Without pupil dilation; acquired with a NIDEK AFC-230:
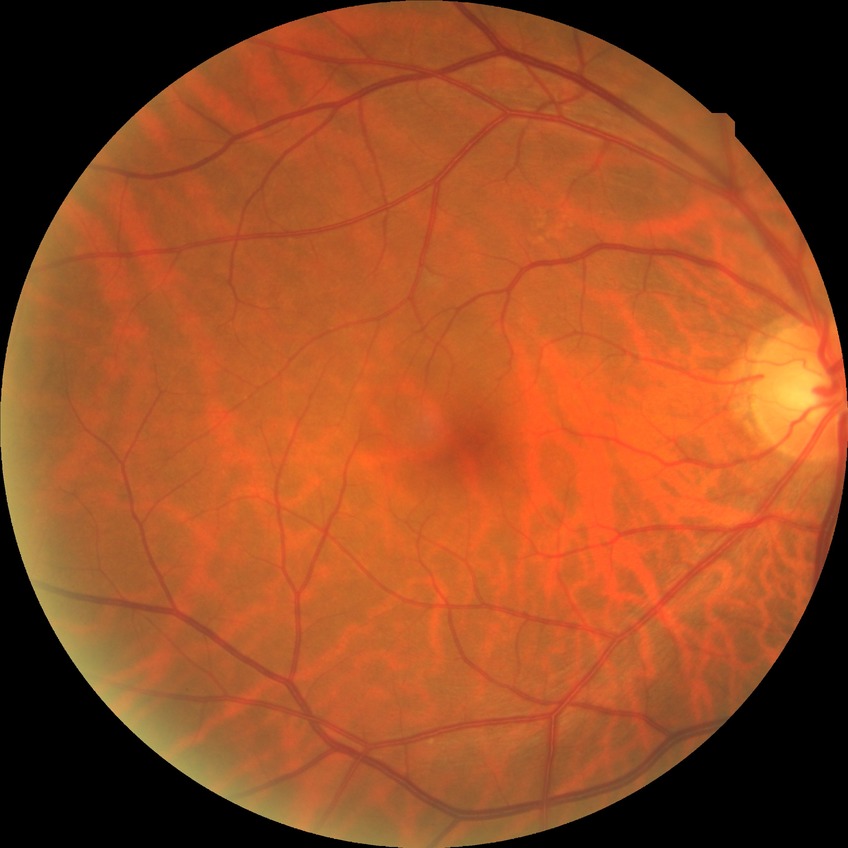
Diabetic retinopathy (DR): no diabetic retinopathy (NDR).